FOV: 45 degrees, color fundus image: 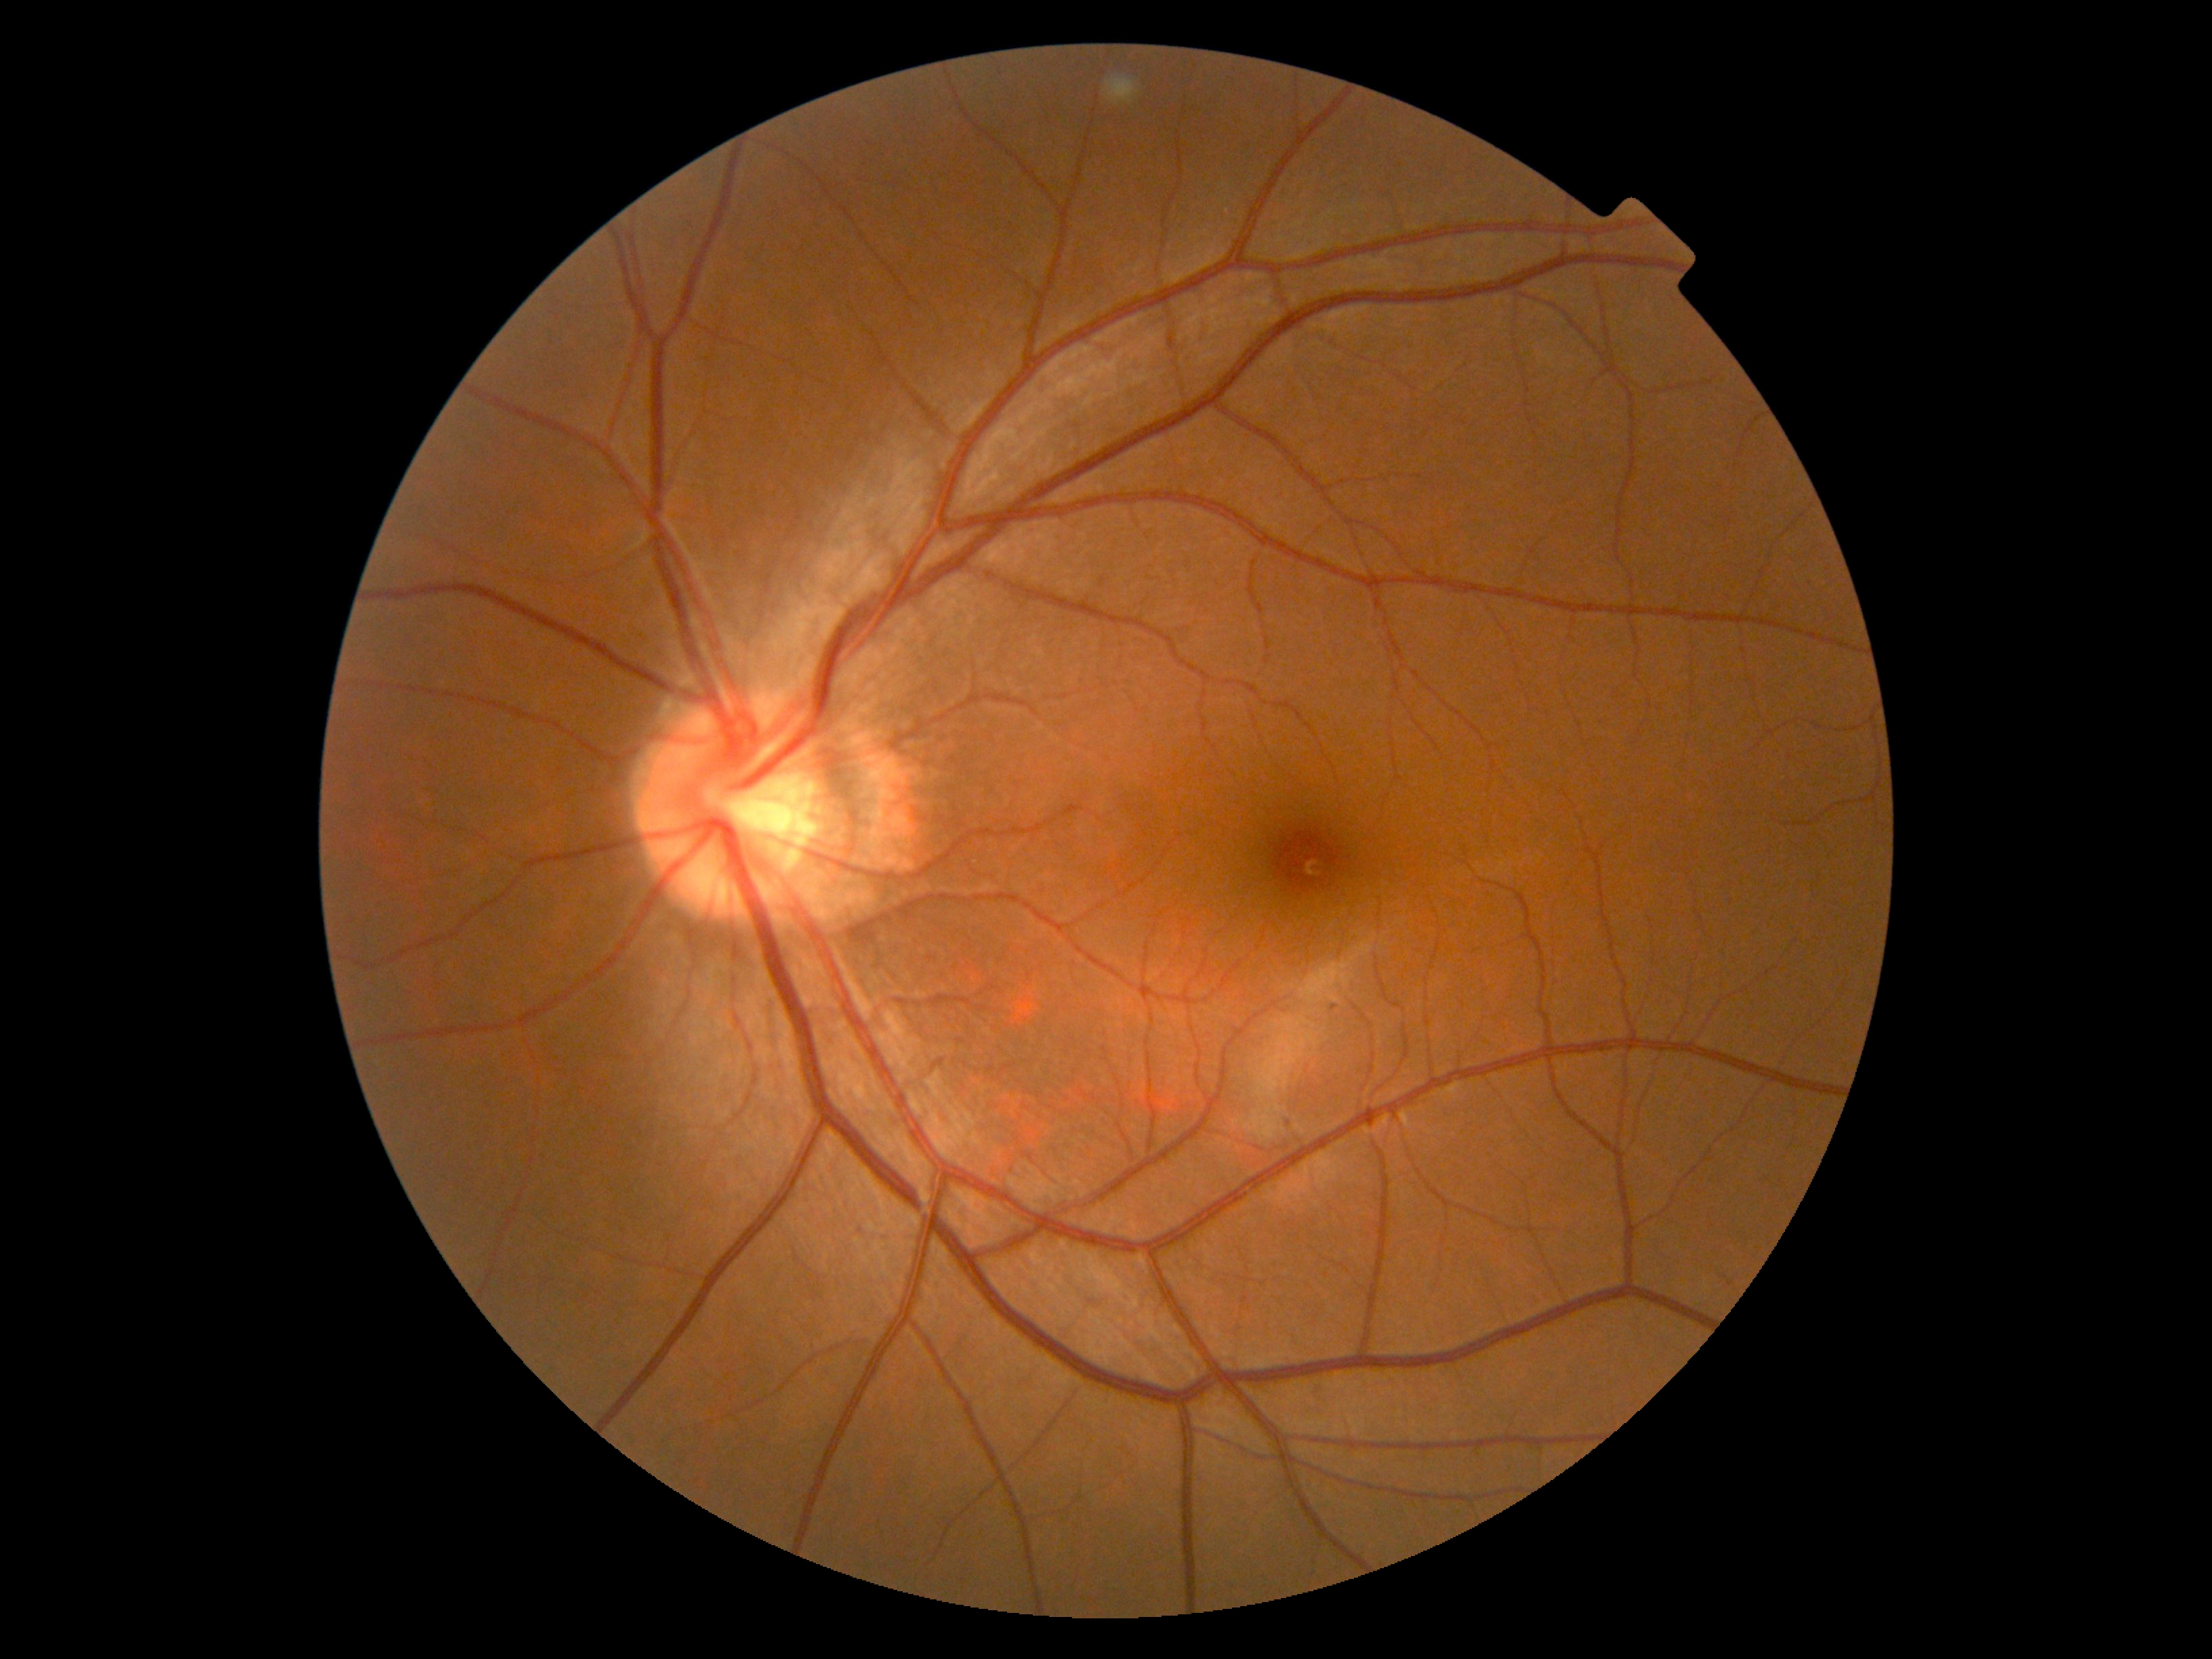

No DR findings. DR: 0.